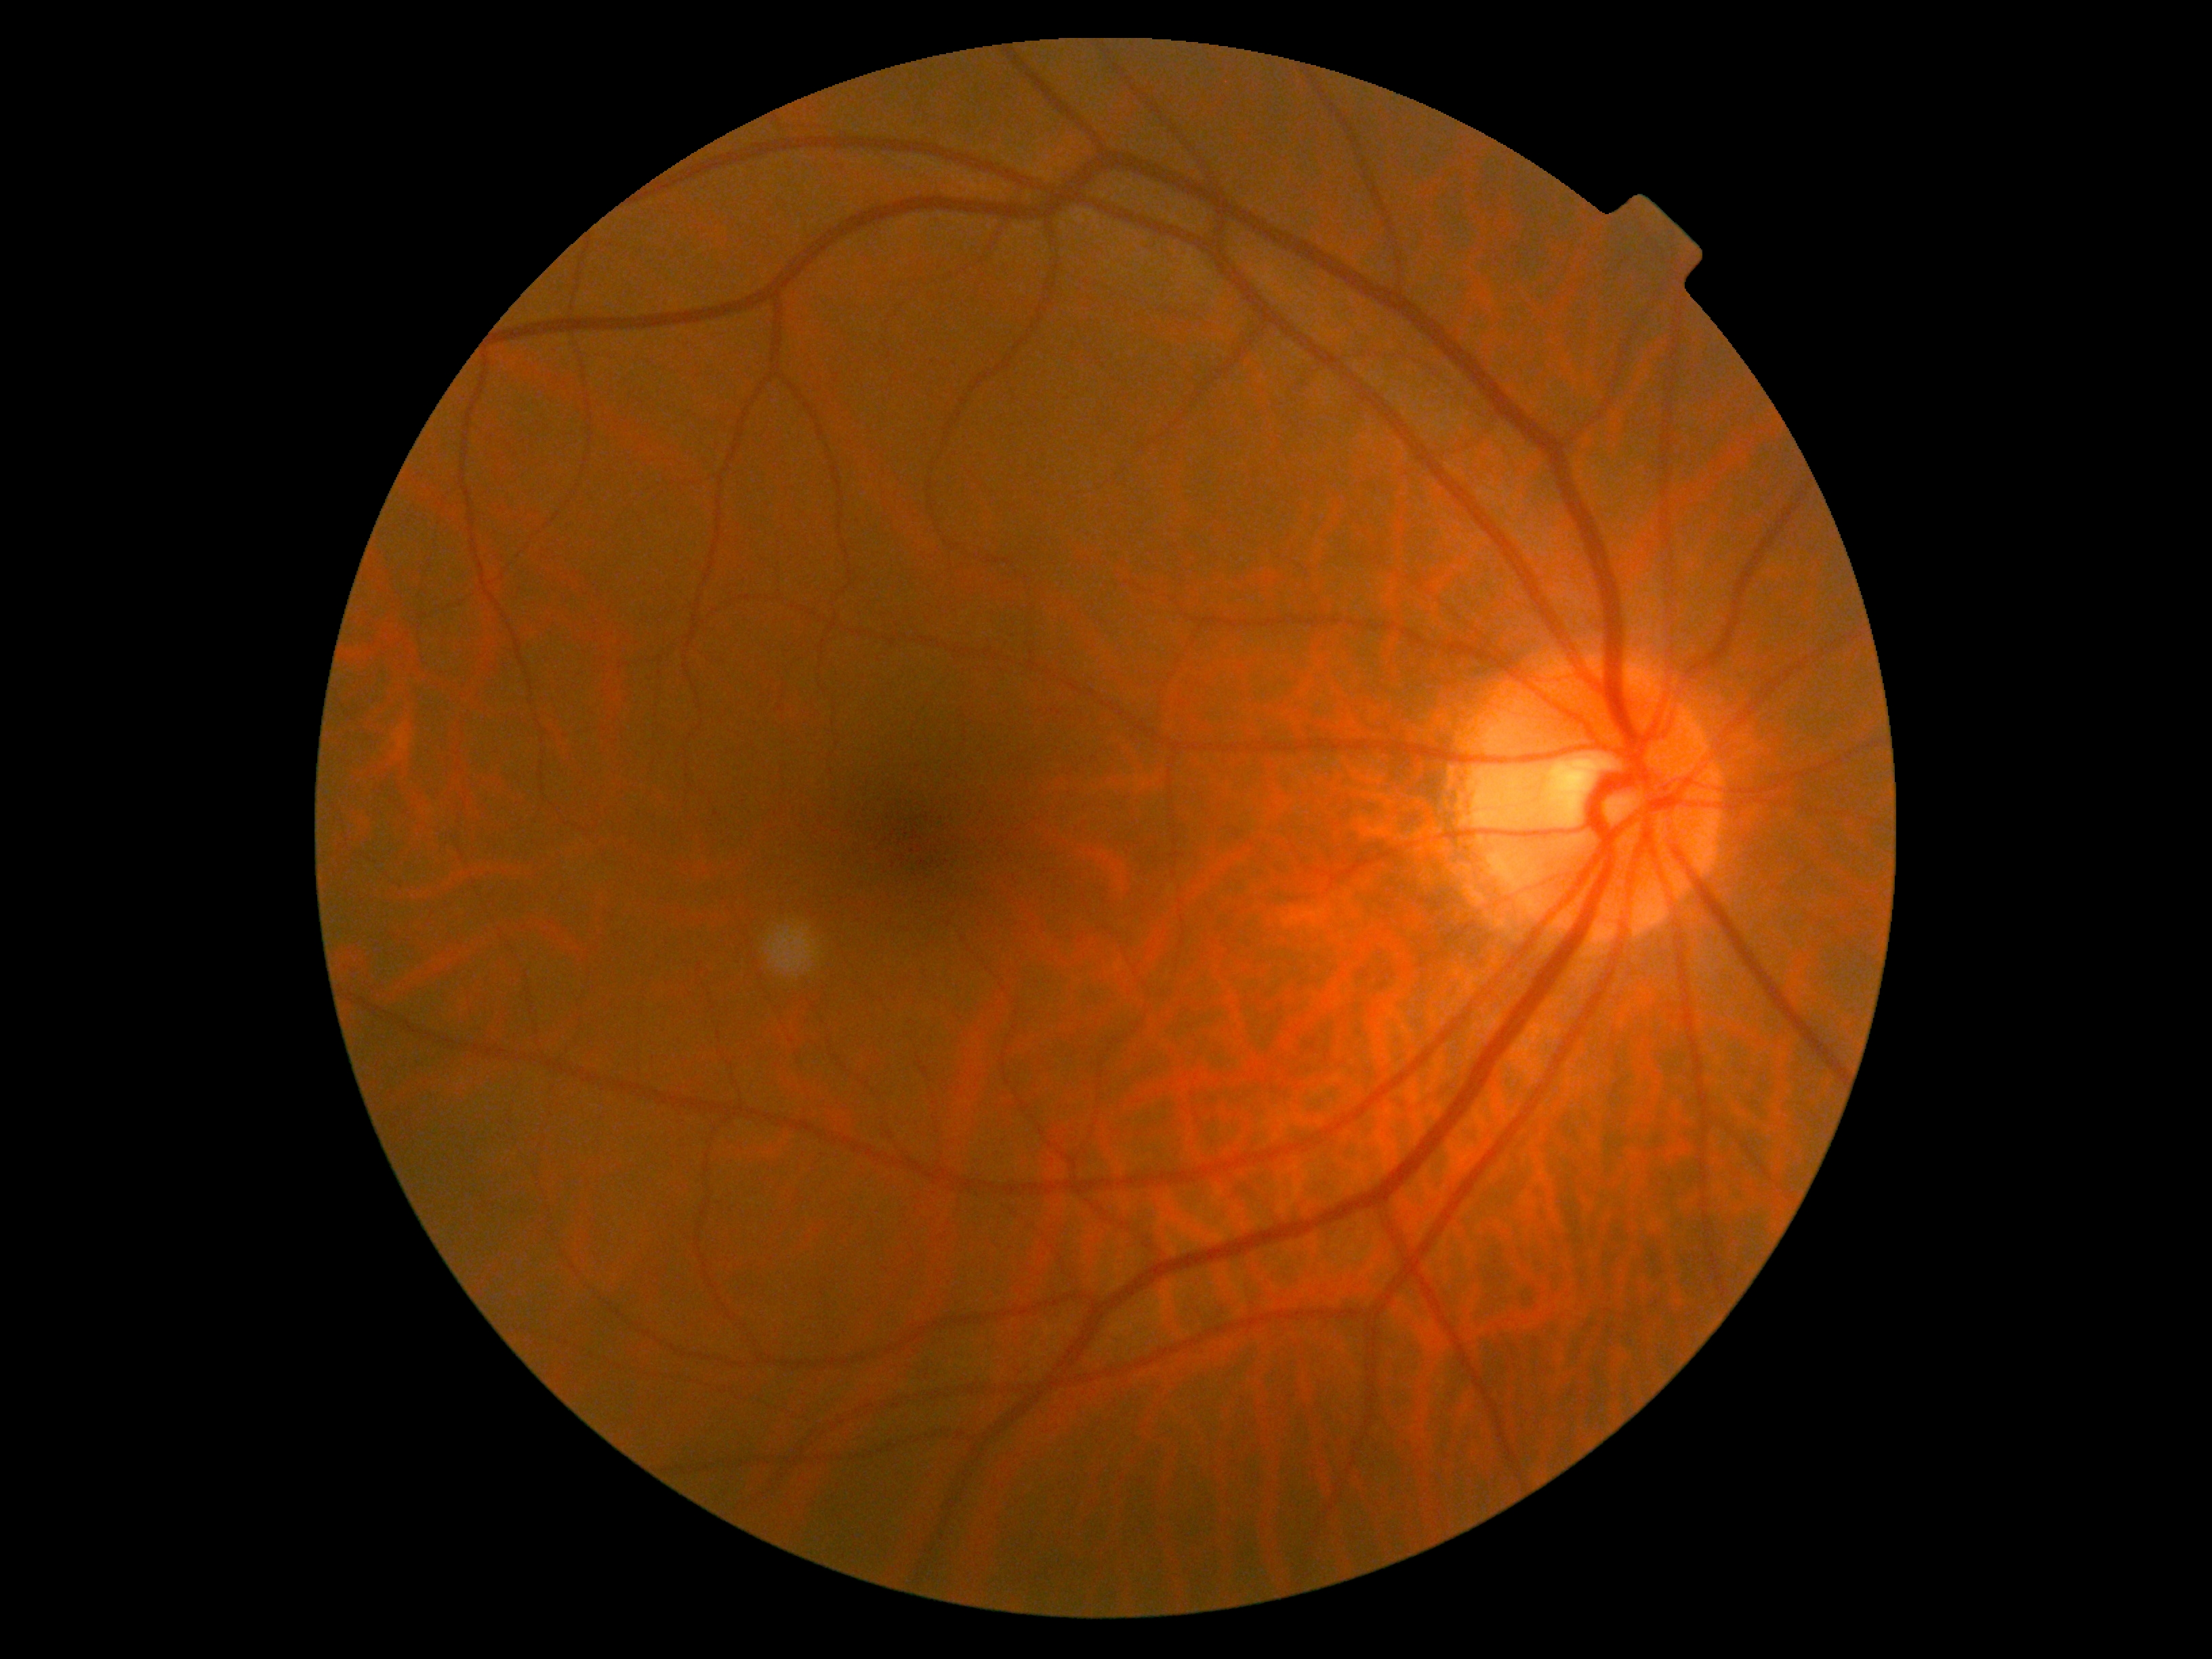
DR is no apparent diabetic retinopathy (grade 0).
No diabetic retinal disease findings.